Pediatric retinal photograph (wide-field).
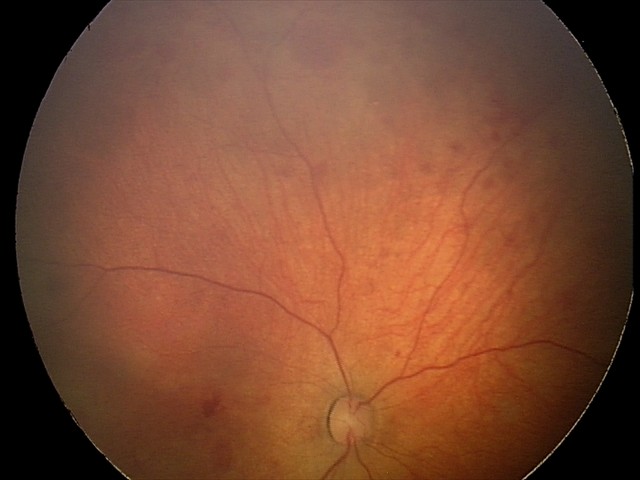 Impression = retinal hemorrhages.